848x848px
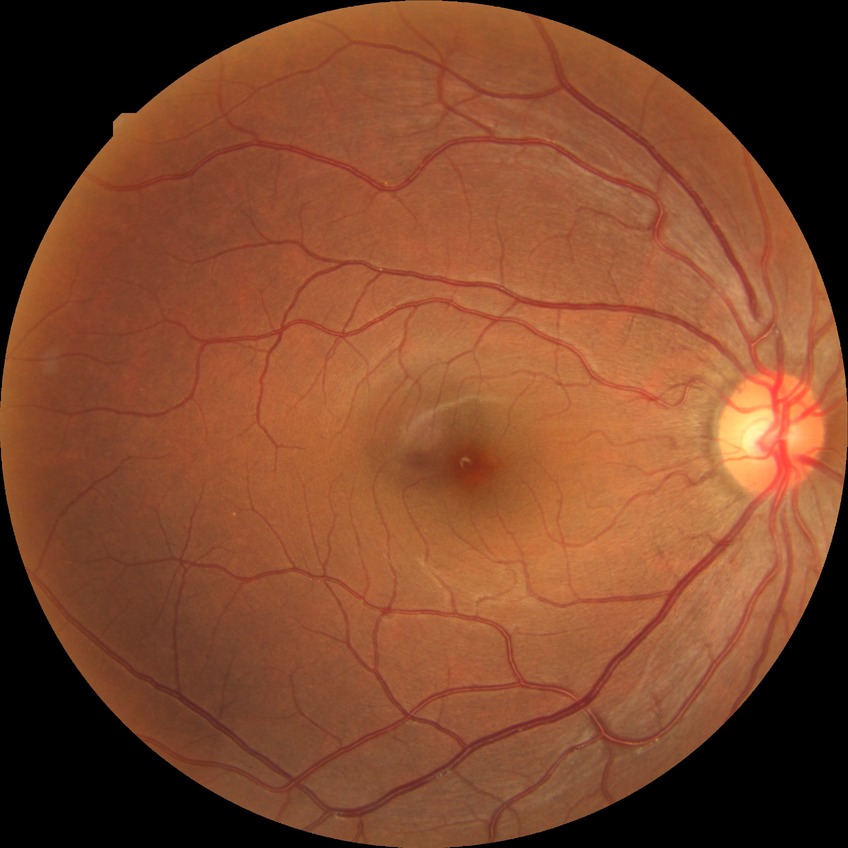

DR severity=NDR; DR impression=no DR findings.